640 x 480 pixels. Pediatric retinal photograph (wide-field) — 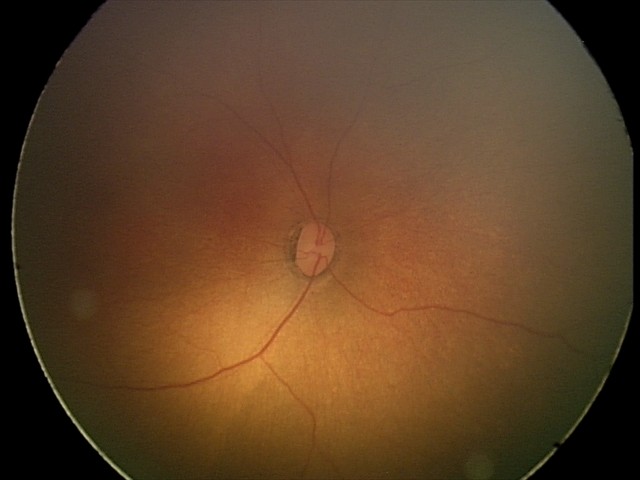 Examination with physiological retinal findings.